1240 by 1240 pixels. Infant wide-field retinal image
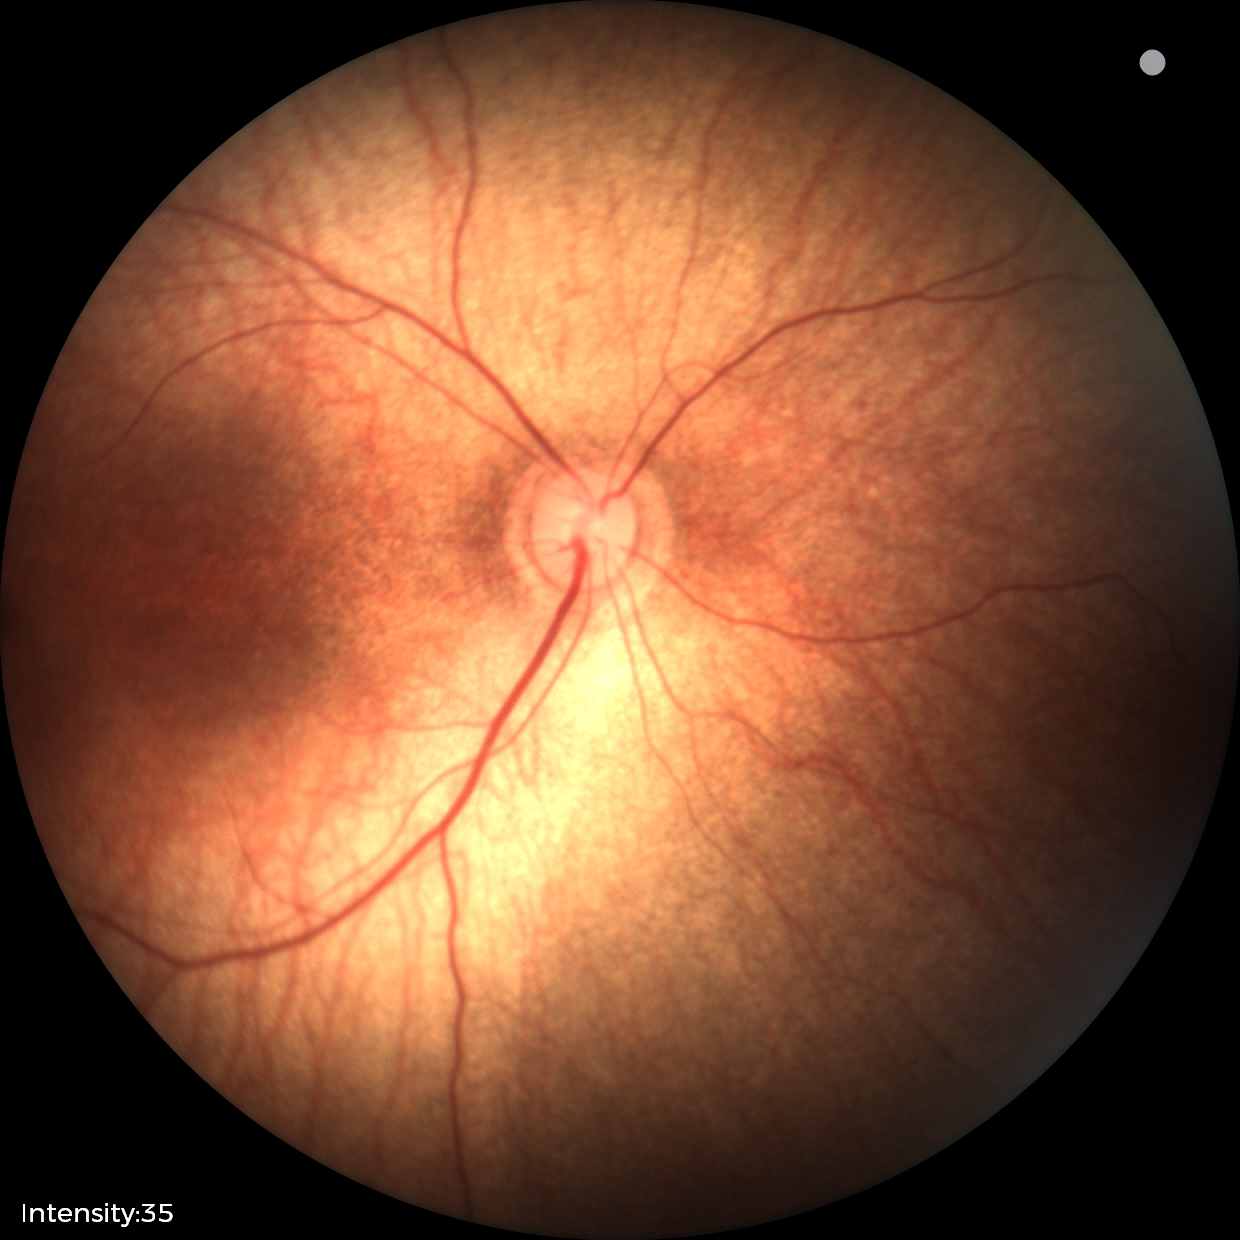
Screening diagnosis = normal.